Fundus image cropped to the optic disc.
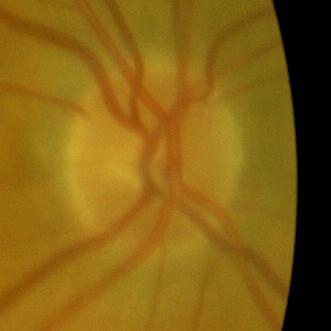
Diagnosis: no glaucomatous findings.